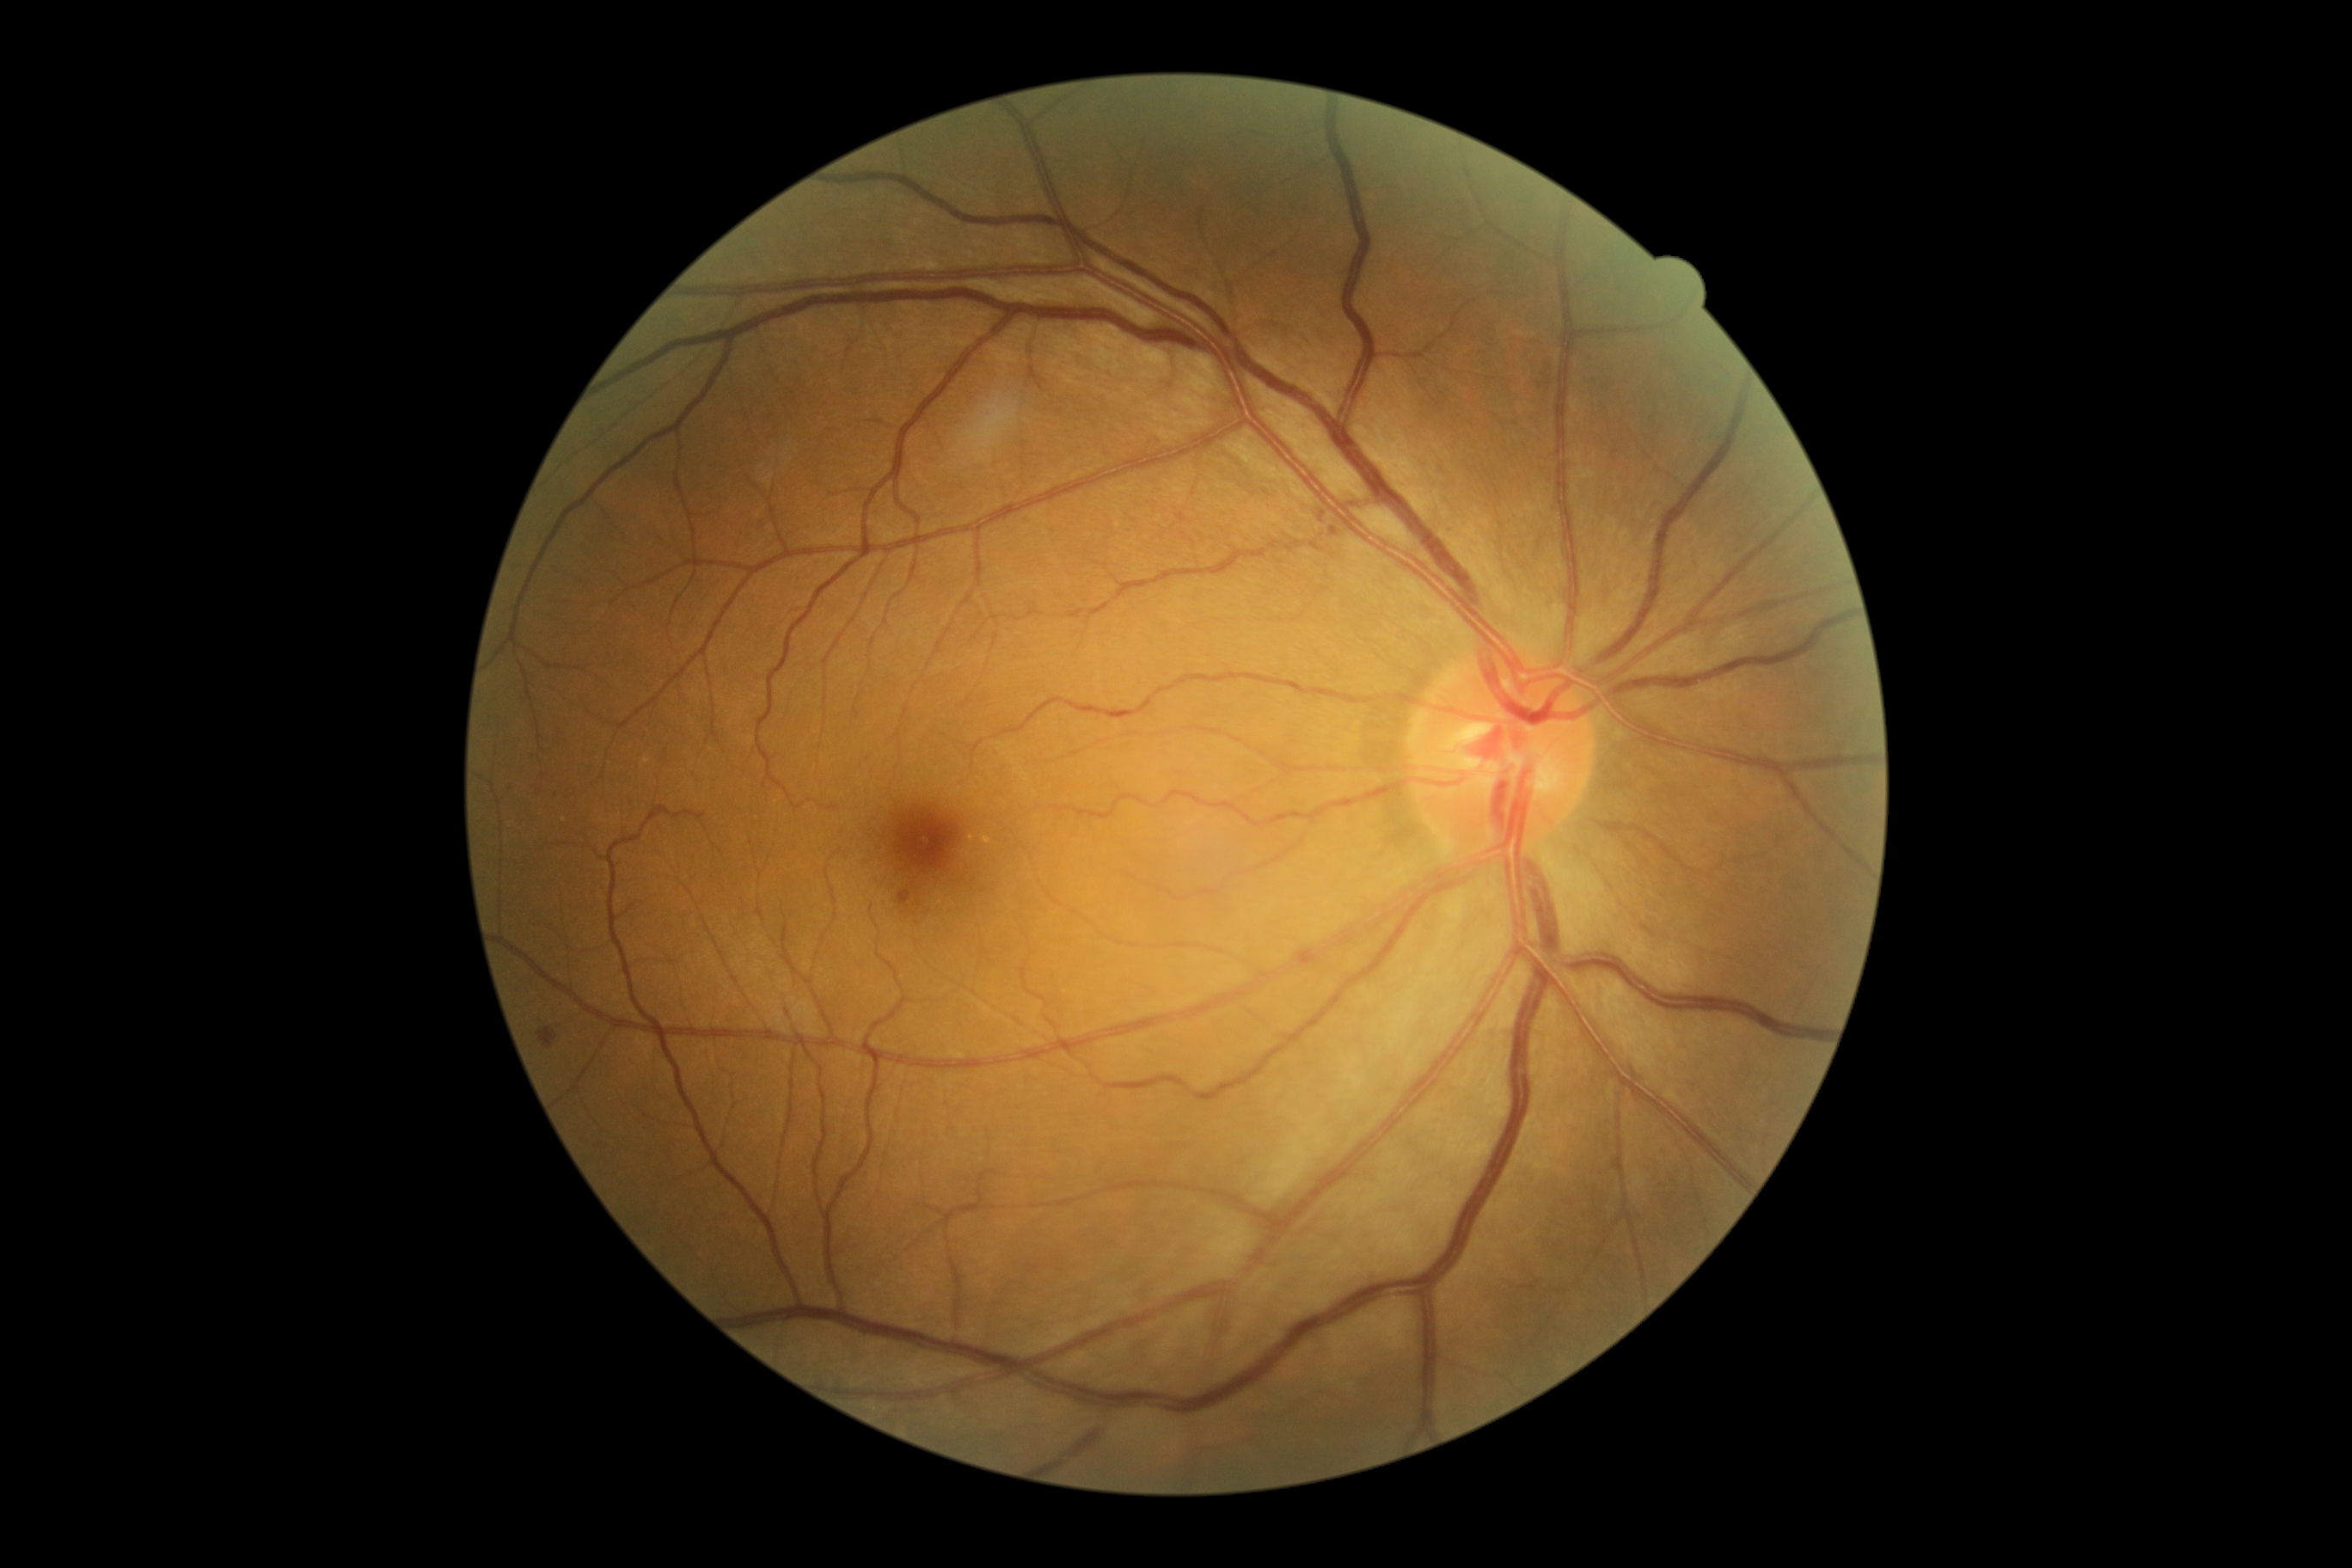
DR class=non-proliferative diabetic retinopathy, diabetic retinopathy severity=grade 2 (moderate NPDR).